Infant wide-field fundus photograph.
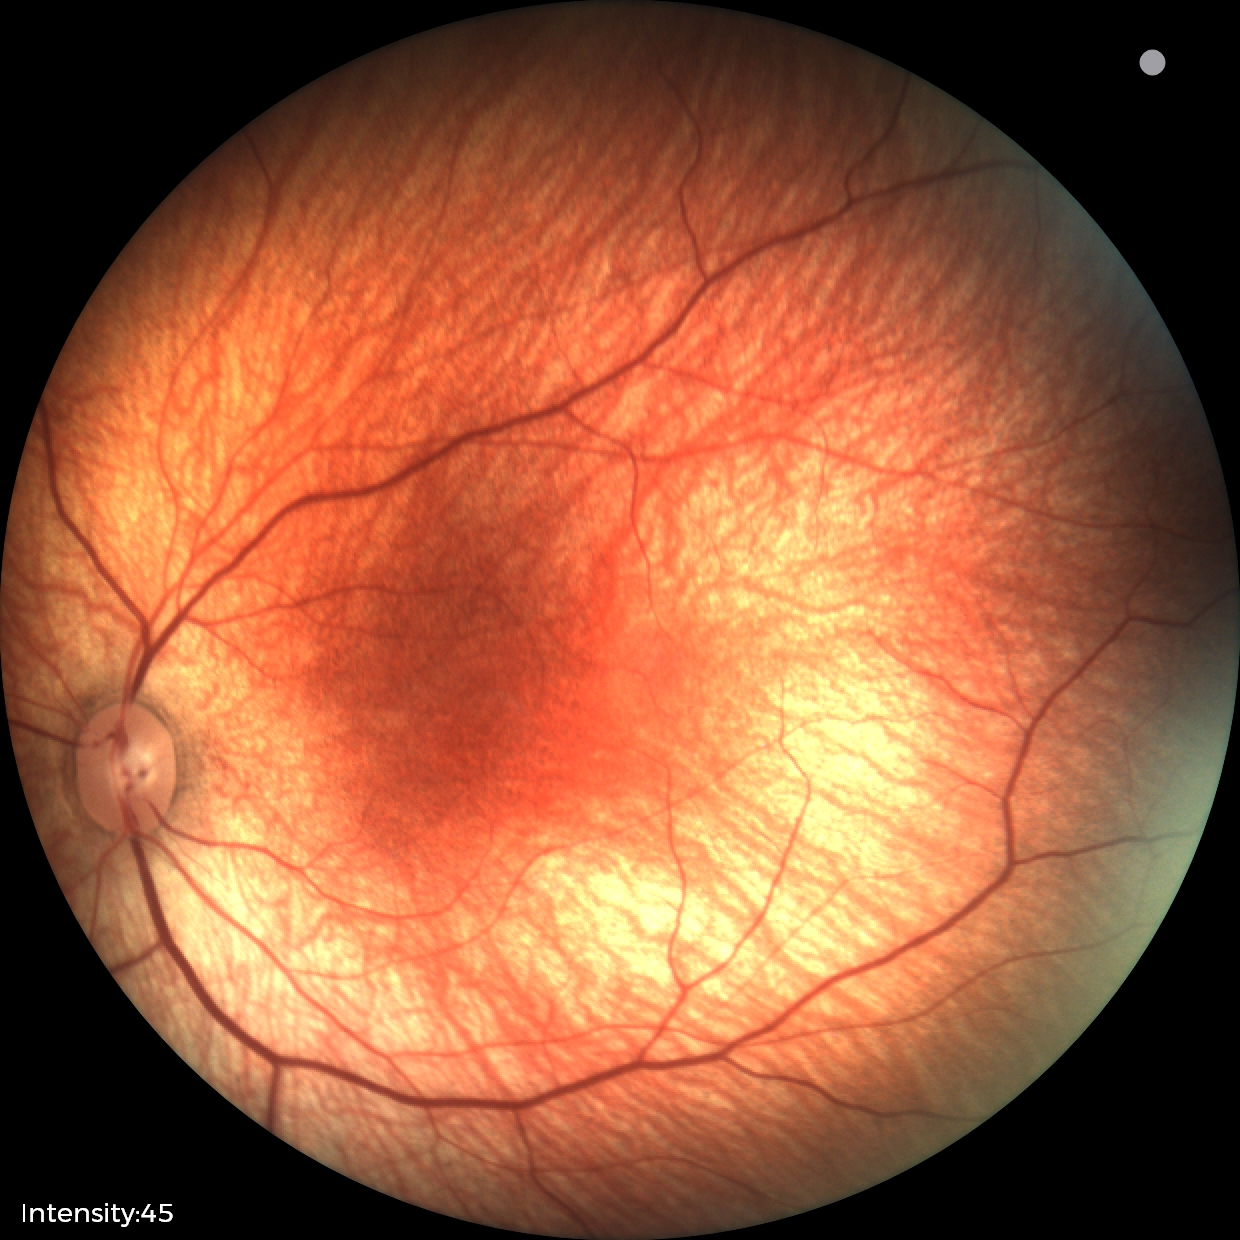 Screening examination diagnosed as physiological.